Camera: Kowa VX-10α; 2361x1568:
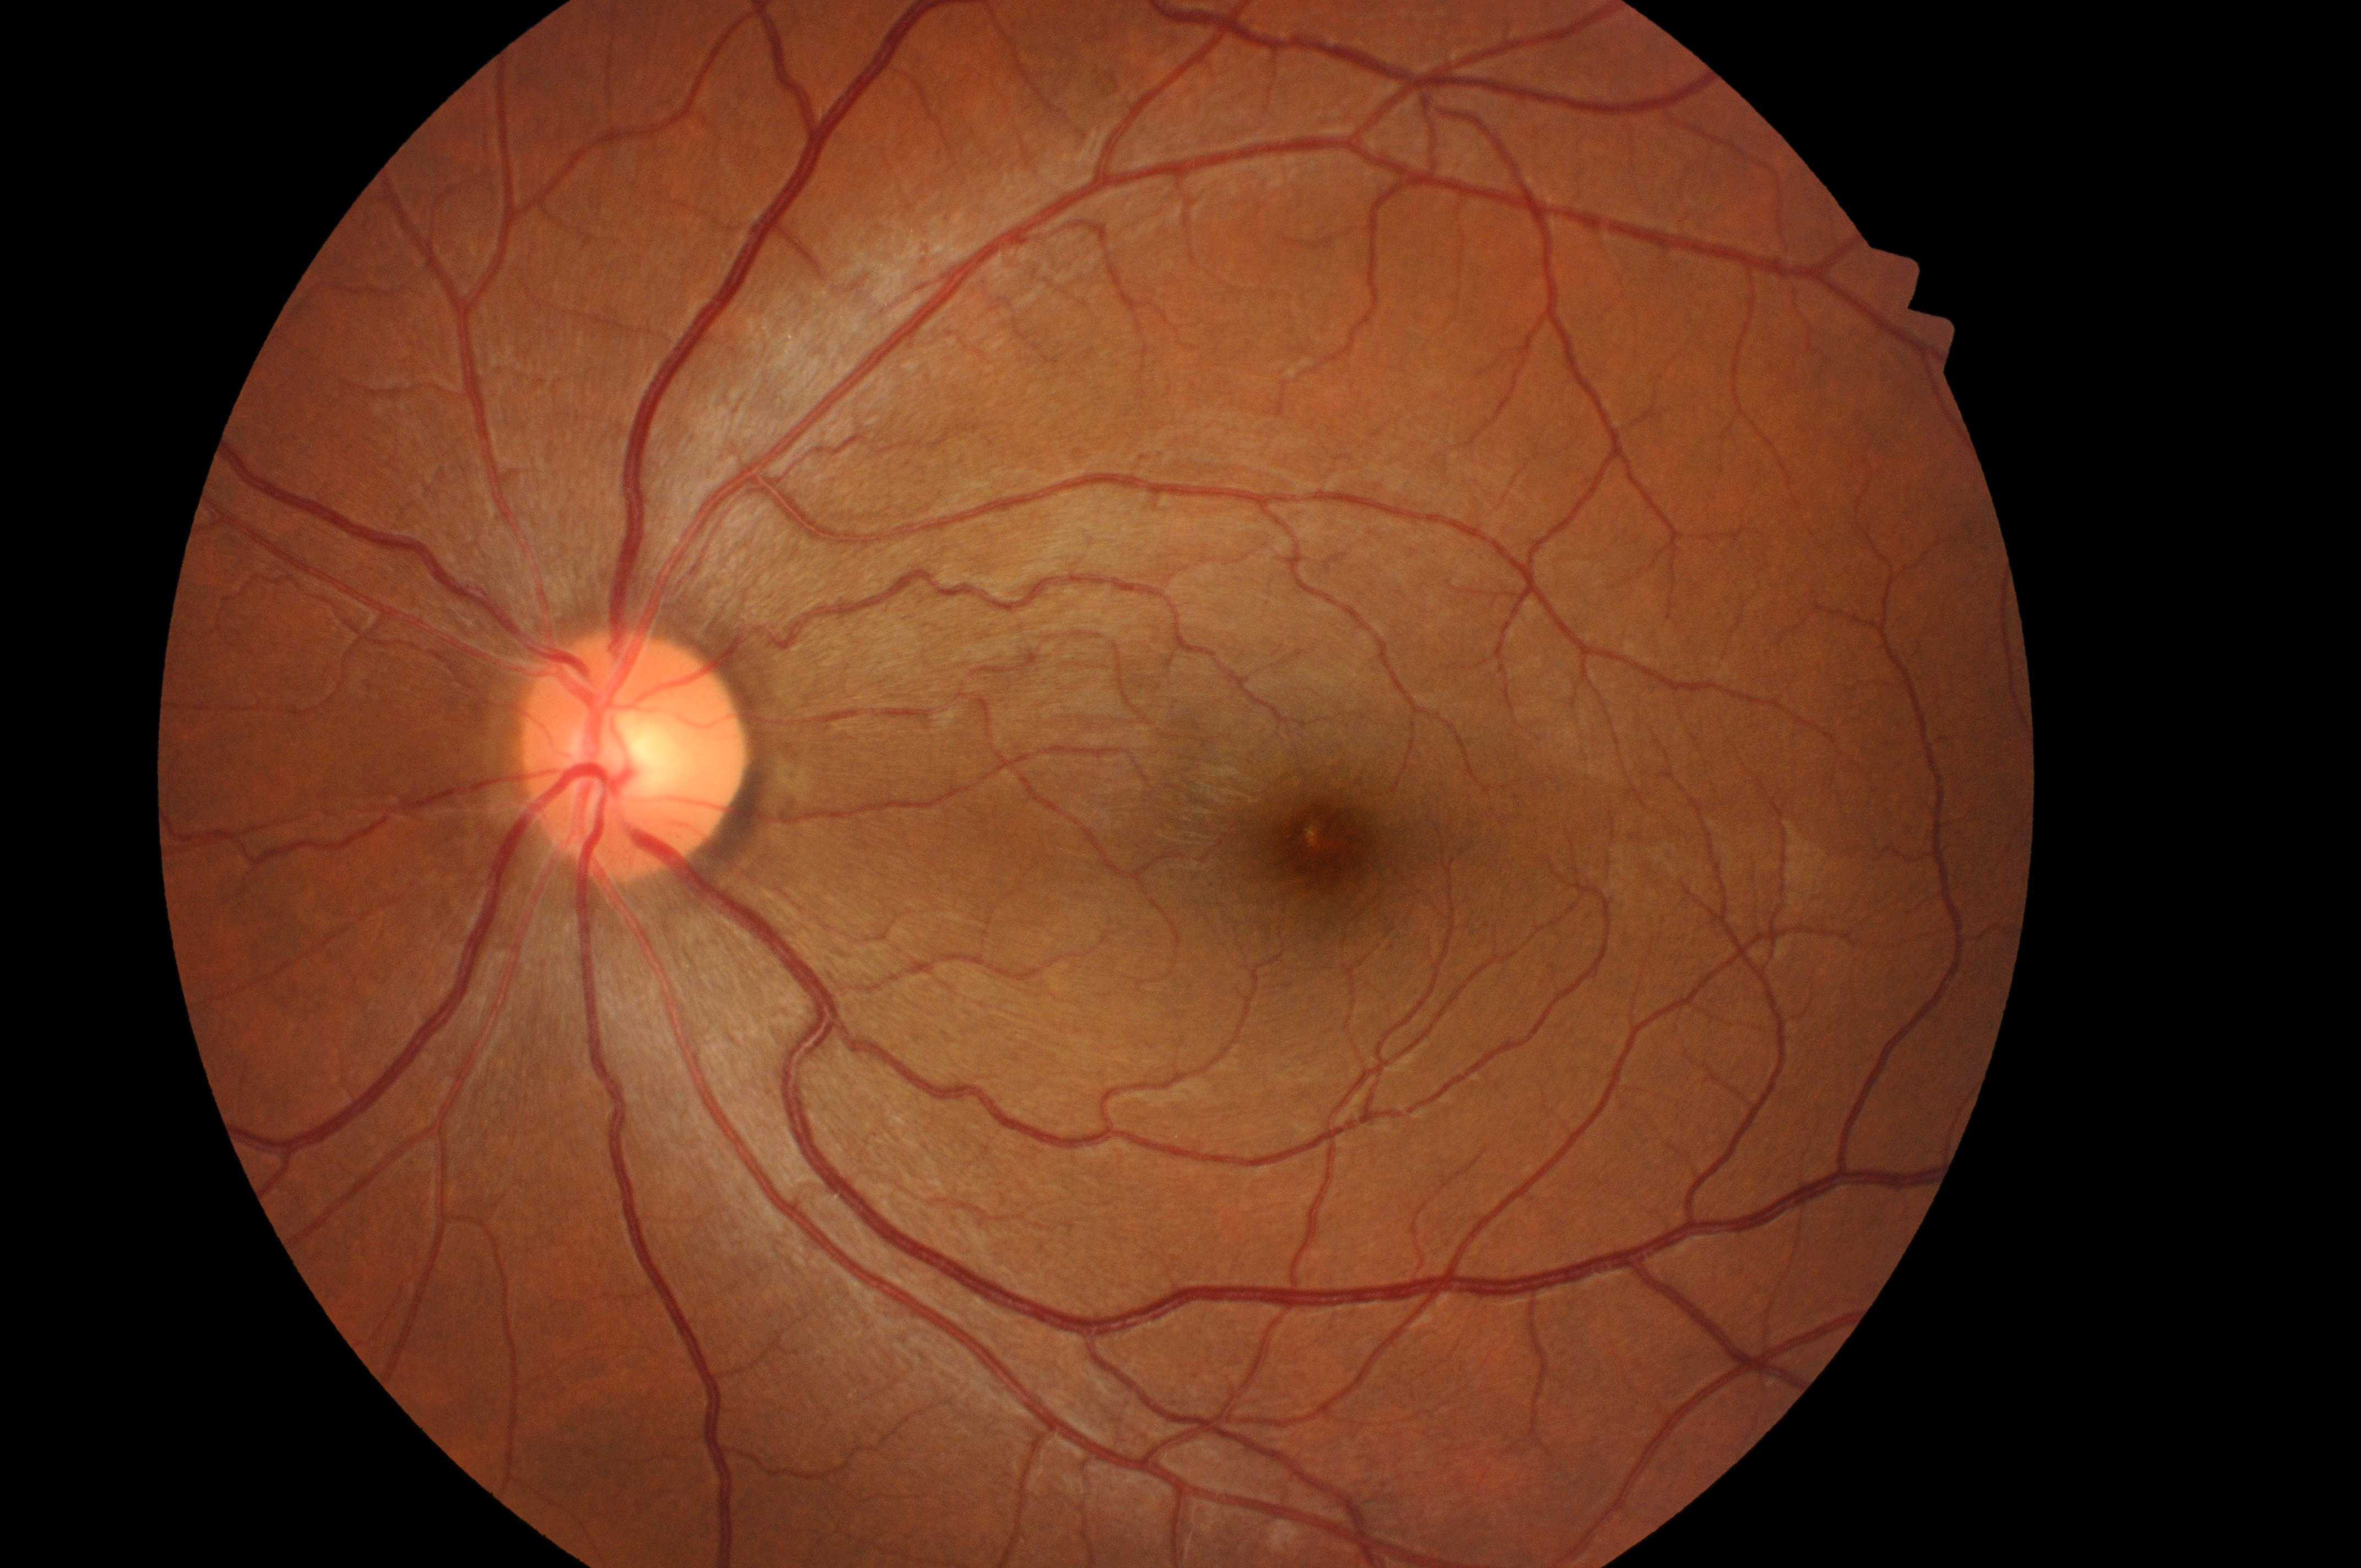 | feature | annotation |
|---|---|
| DME | 0 |
| DR grade | 0 |
| disc center | (x=627, y=760) |
| fovea centralis | (x=1328, y=847) |
| laterality | left eye |